50° field of view, captured on a Topcon TRC-50DX fundus camera, posterior pole view:
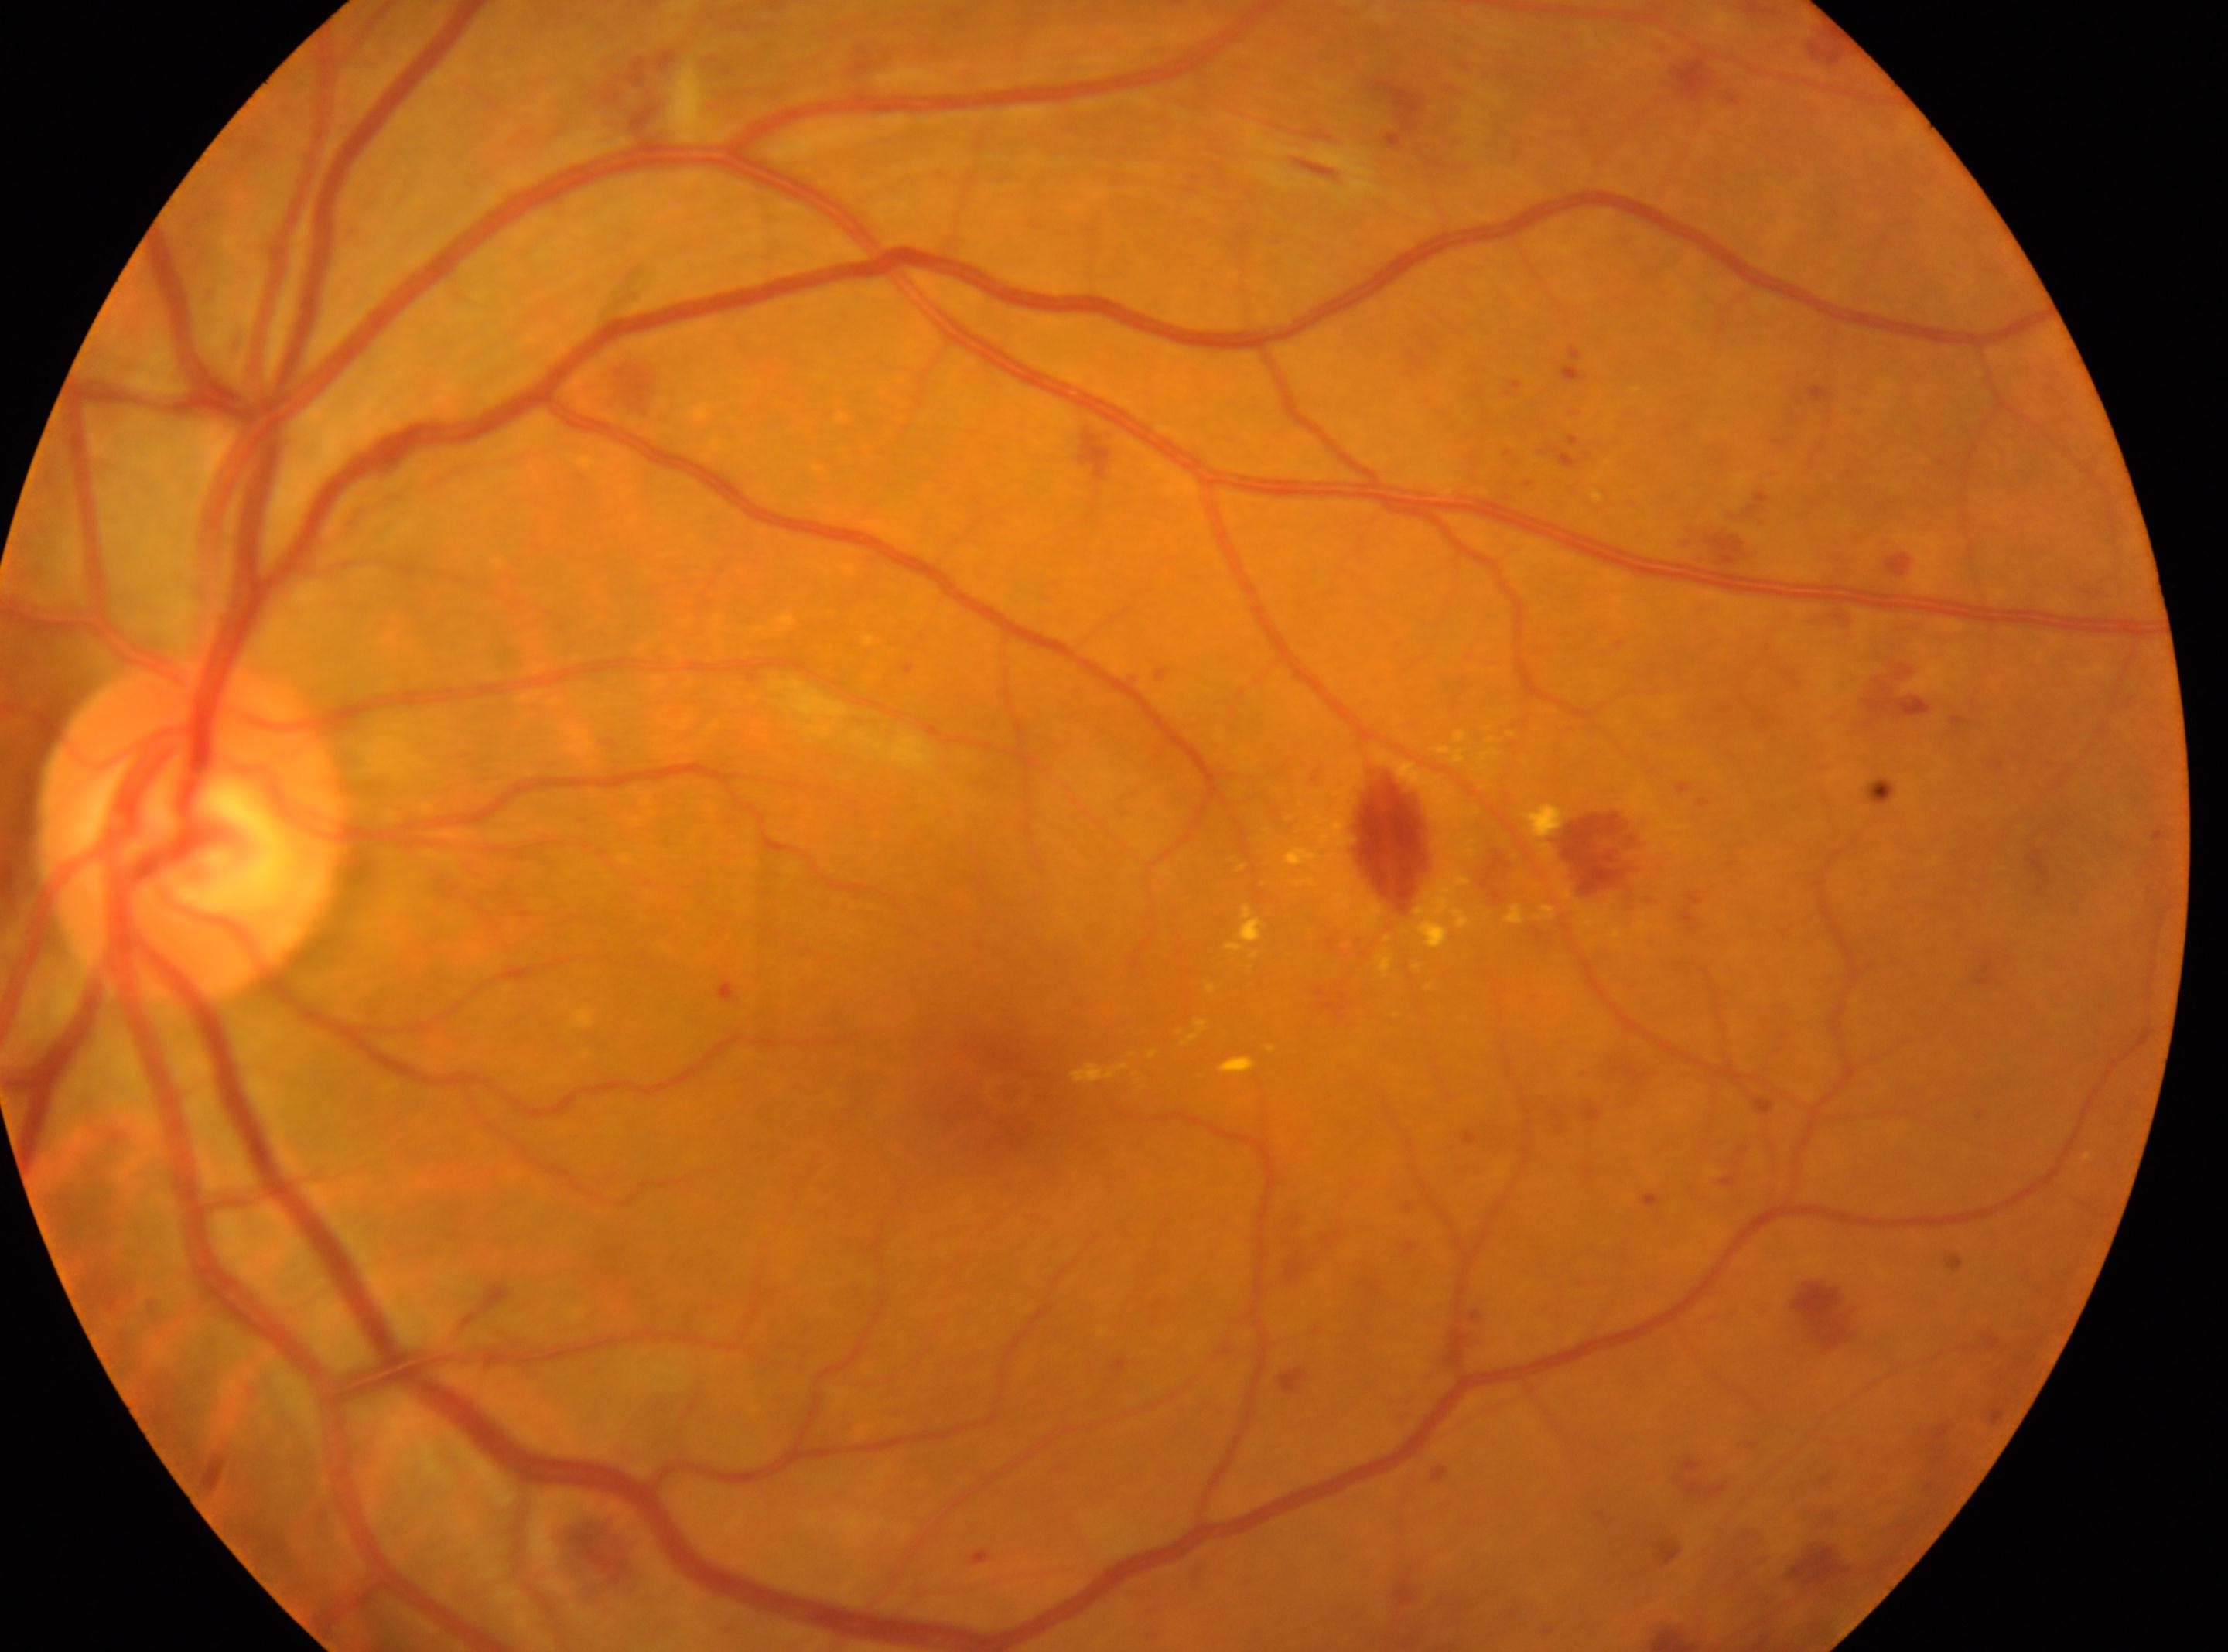

Findings:
– DR class: non-proliferative diabetic retinopathy
– foveal center: (x: 998, y: 1094)
– optic disc: (x: 192, y: 834)
– diabetic retinopathy grade: 2
– laterality: left